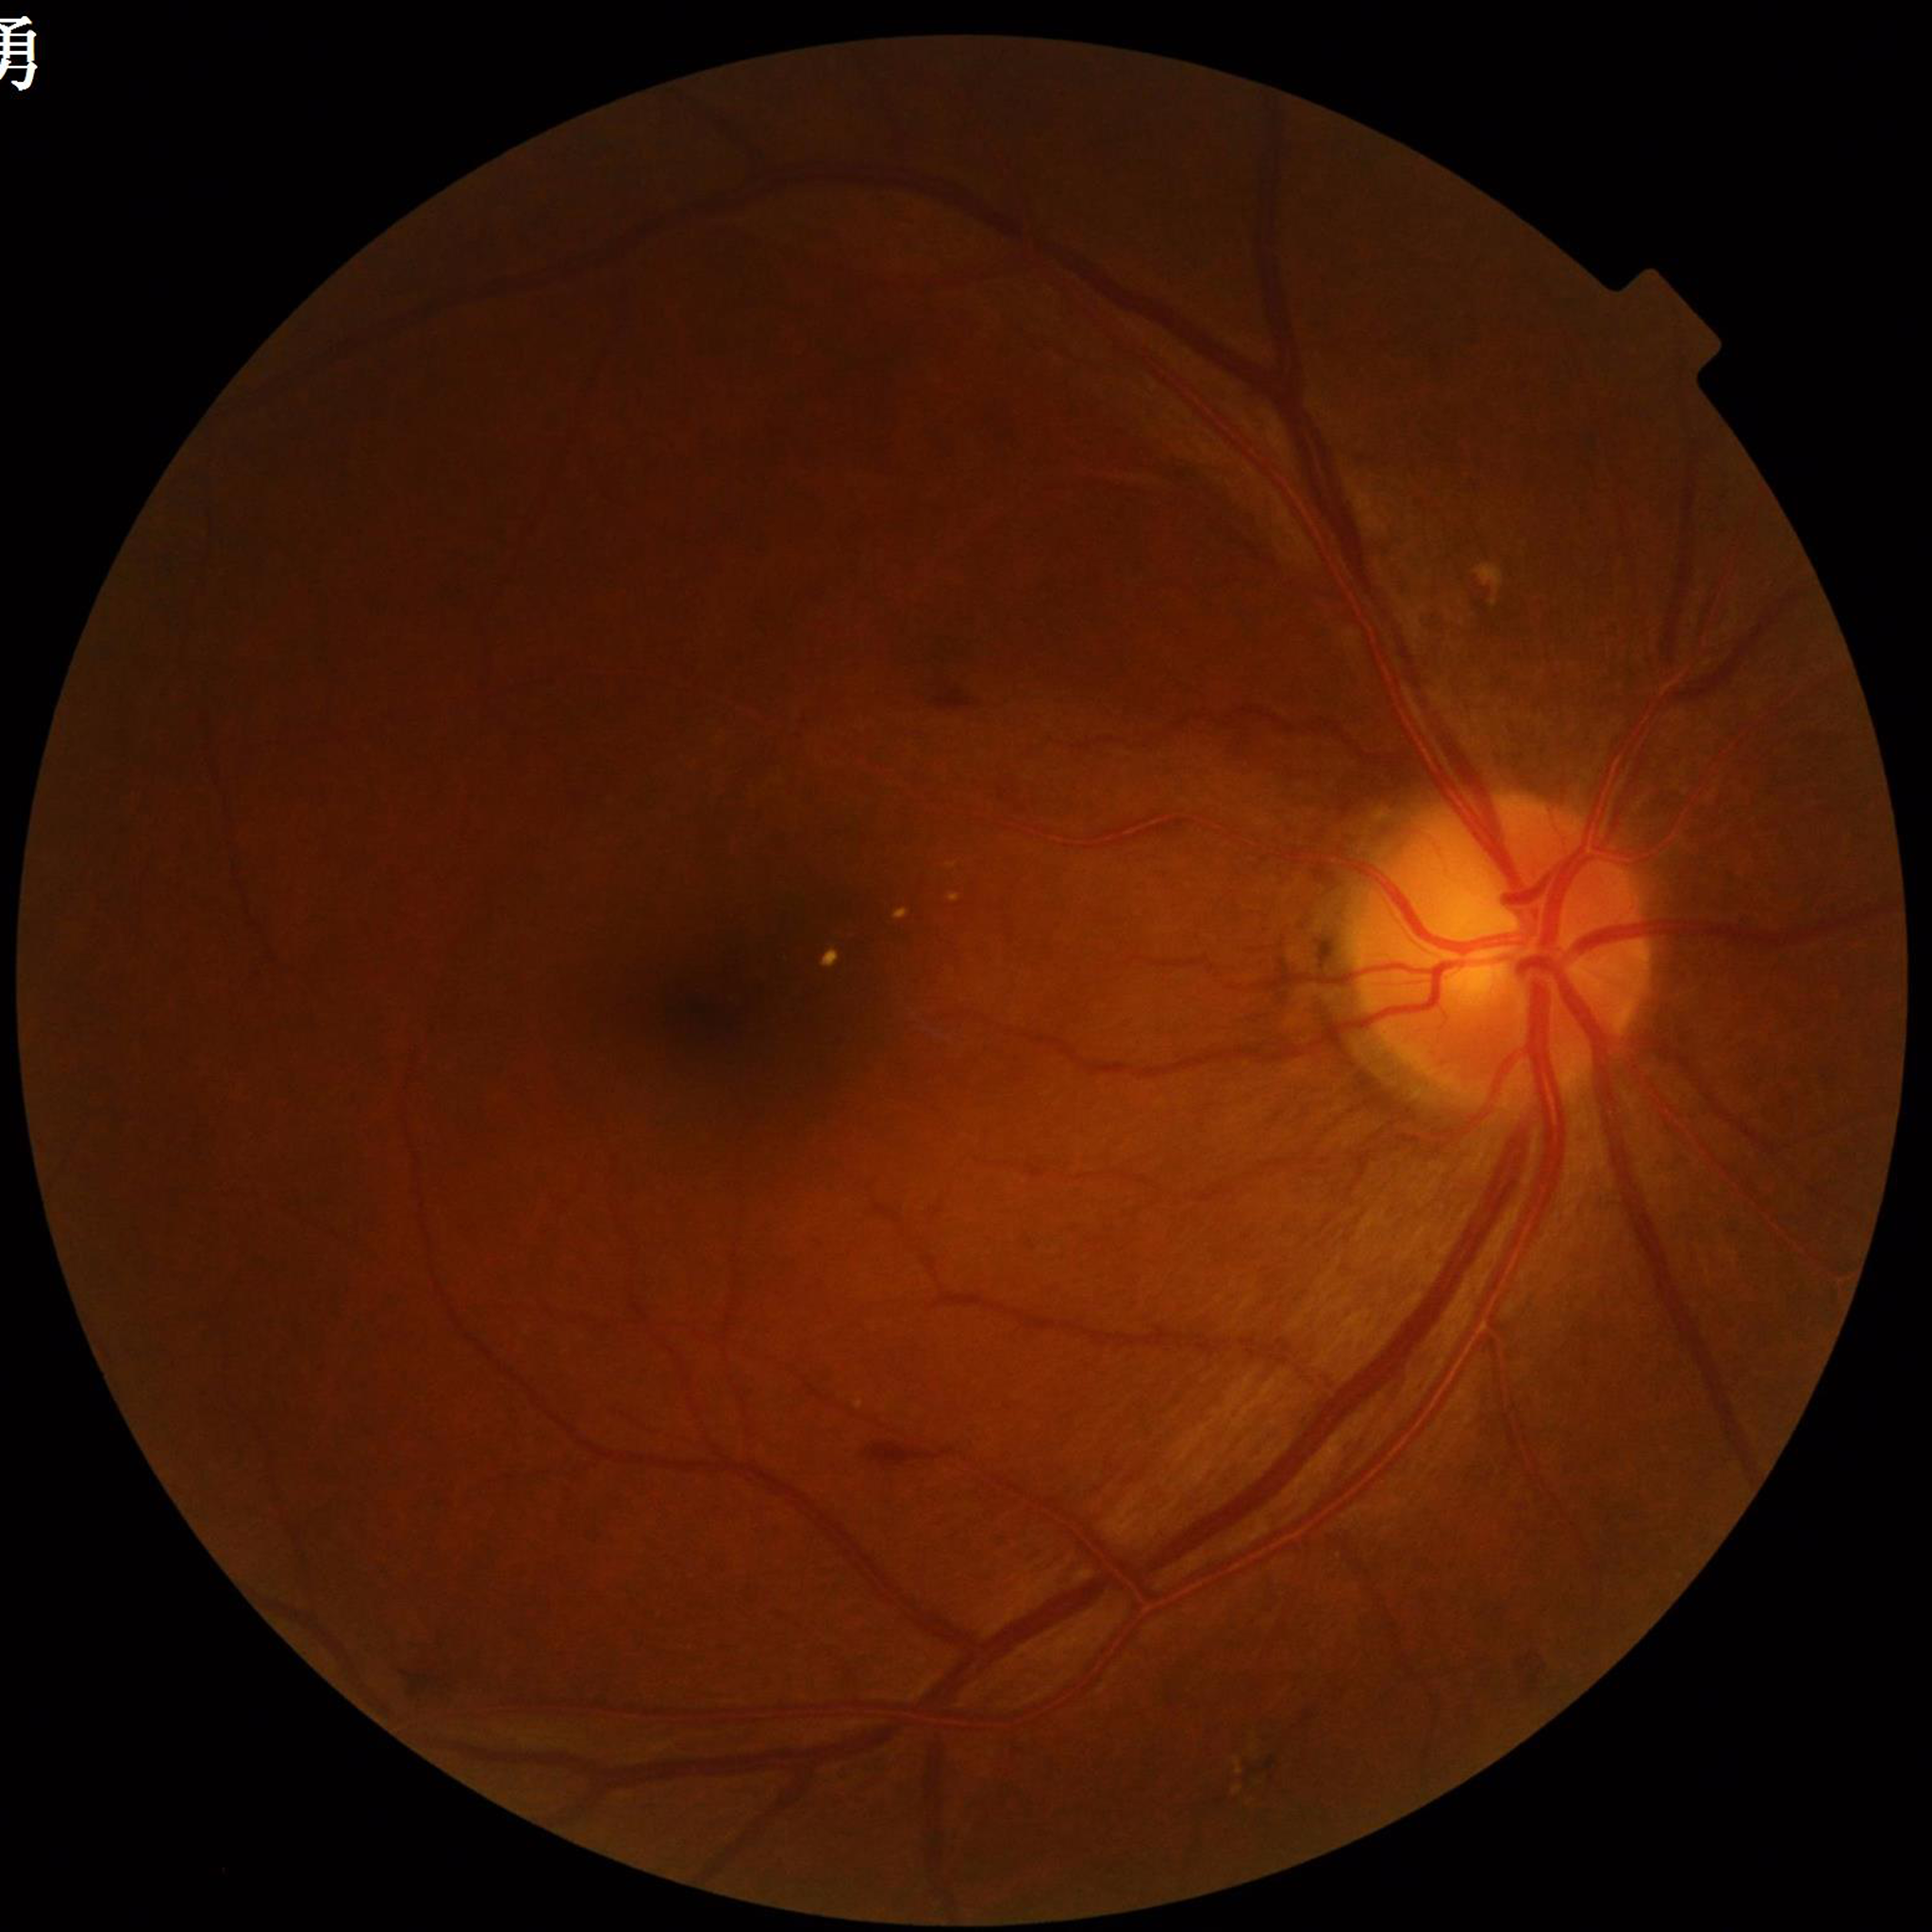
{"diagnosis": "diabetic retinopathy"}